Color fundus photograph · 45° field of view
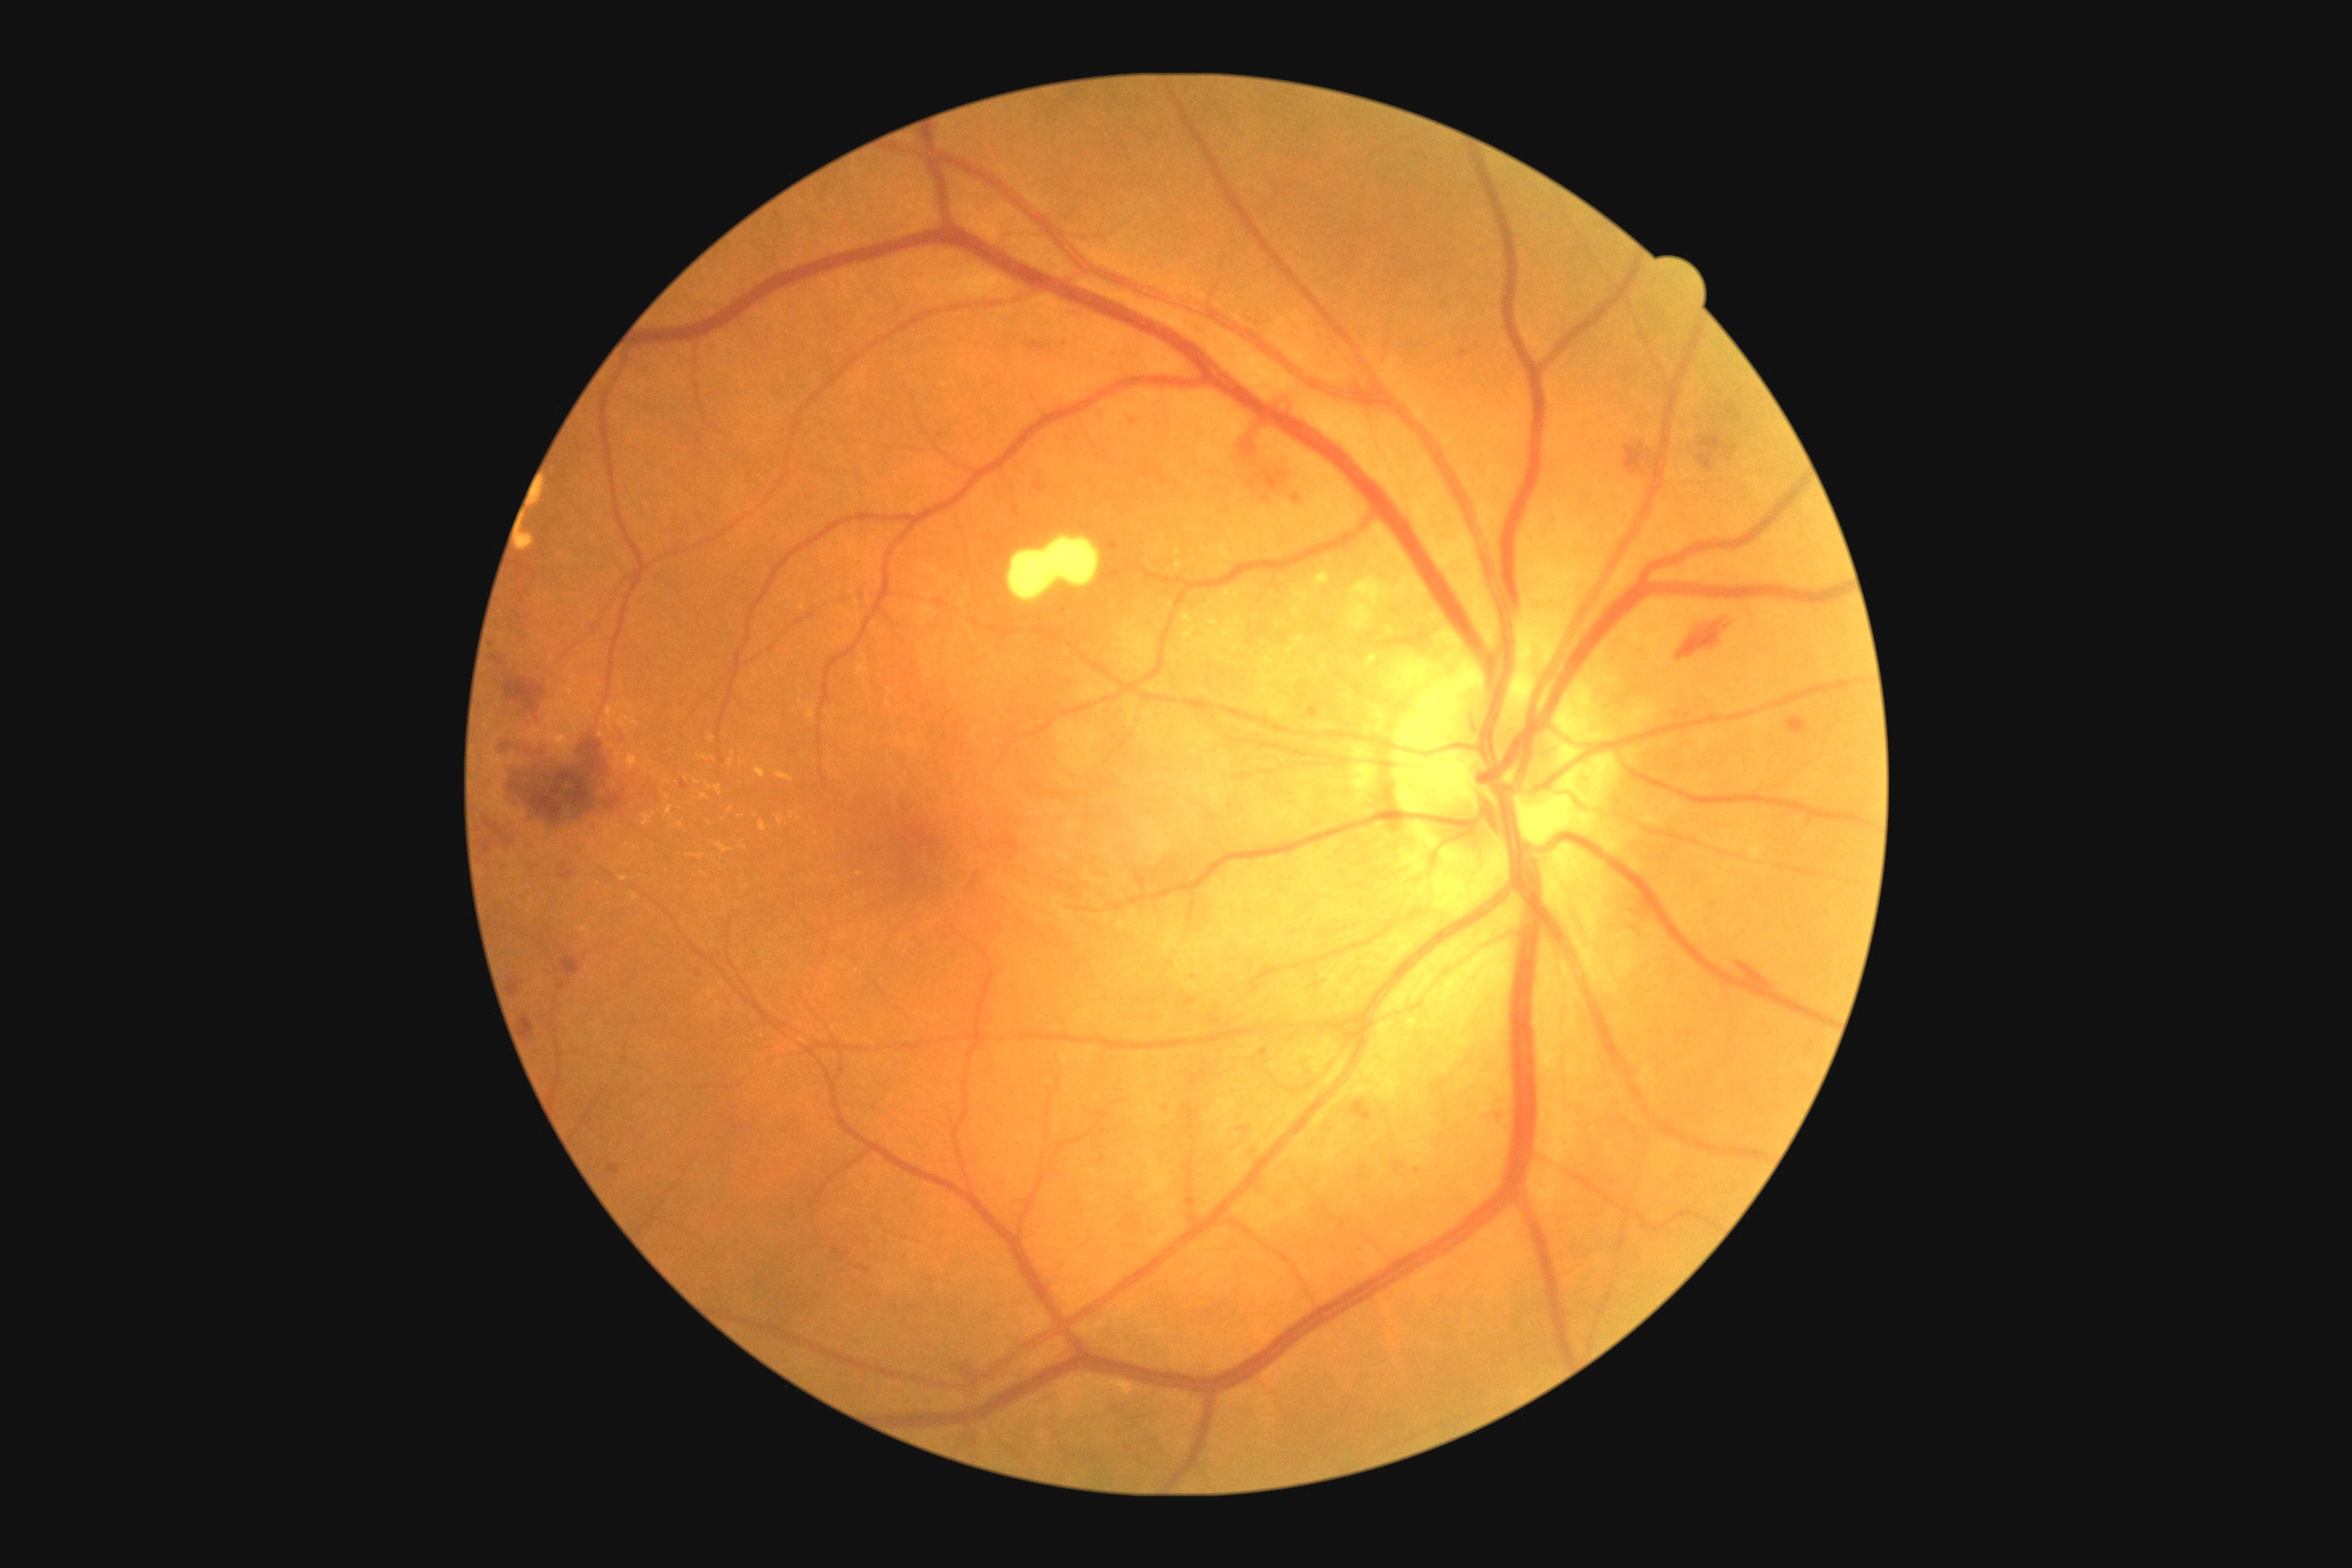
partial: true
dr_grade: 2
lesions:
  se: []
  he:
    - BBox(1458, 349, 1471, 358)
    - BBox(1161, 1102, 1171, 1117)
    - BBox(1360, 1166, 1367, 1181)
    - BBox(1019, 337, 1072, 353)
    - BBox(491, 647, 547, 727)
    - BBox(1787, 718, 1807, 736)
    - BBox(1186, 999, 1197, 1006)
    - BBox(1625, 894, 1658, 937)
    - BBox(1542, 513, 1560, 529)
    - BBox(1351, 1101, 1373, 1121)
    - BBox(493, 725, 667, 838)
  he_small_approx:
    - [561,986]
    - [698,975]
    - [1245,1130]
    - [1179,487]
    - [836,1252]
  ma: []
  ex:
    - BBox(1184, 614, 1195, 642)
    - BBox(776, 770, 794, 783)
    - BBox(729, 760, 734, 769)
    - BBox(642, 814, 652, 827)
    - BBox(1224, 591, 1233, 600)
    - BBox(1008, 538, 1101, 603)
    - BBox(676, 823, 685, 830)
    - BBox(716, 843, 732, 854)
    - BBox(756, 767, 767, 778)
  ex_small_approx:
    - [630,708]
    - [793,815]
    - [669,797]
    - [860,874]
    - [734,754]